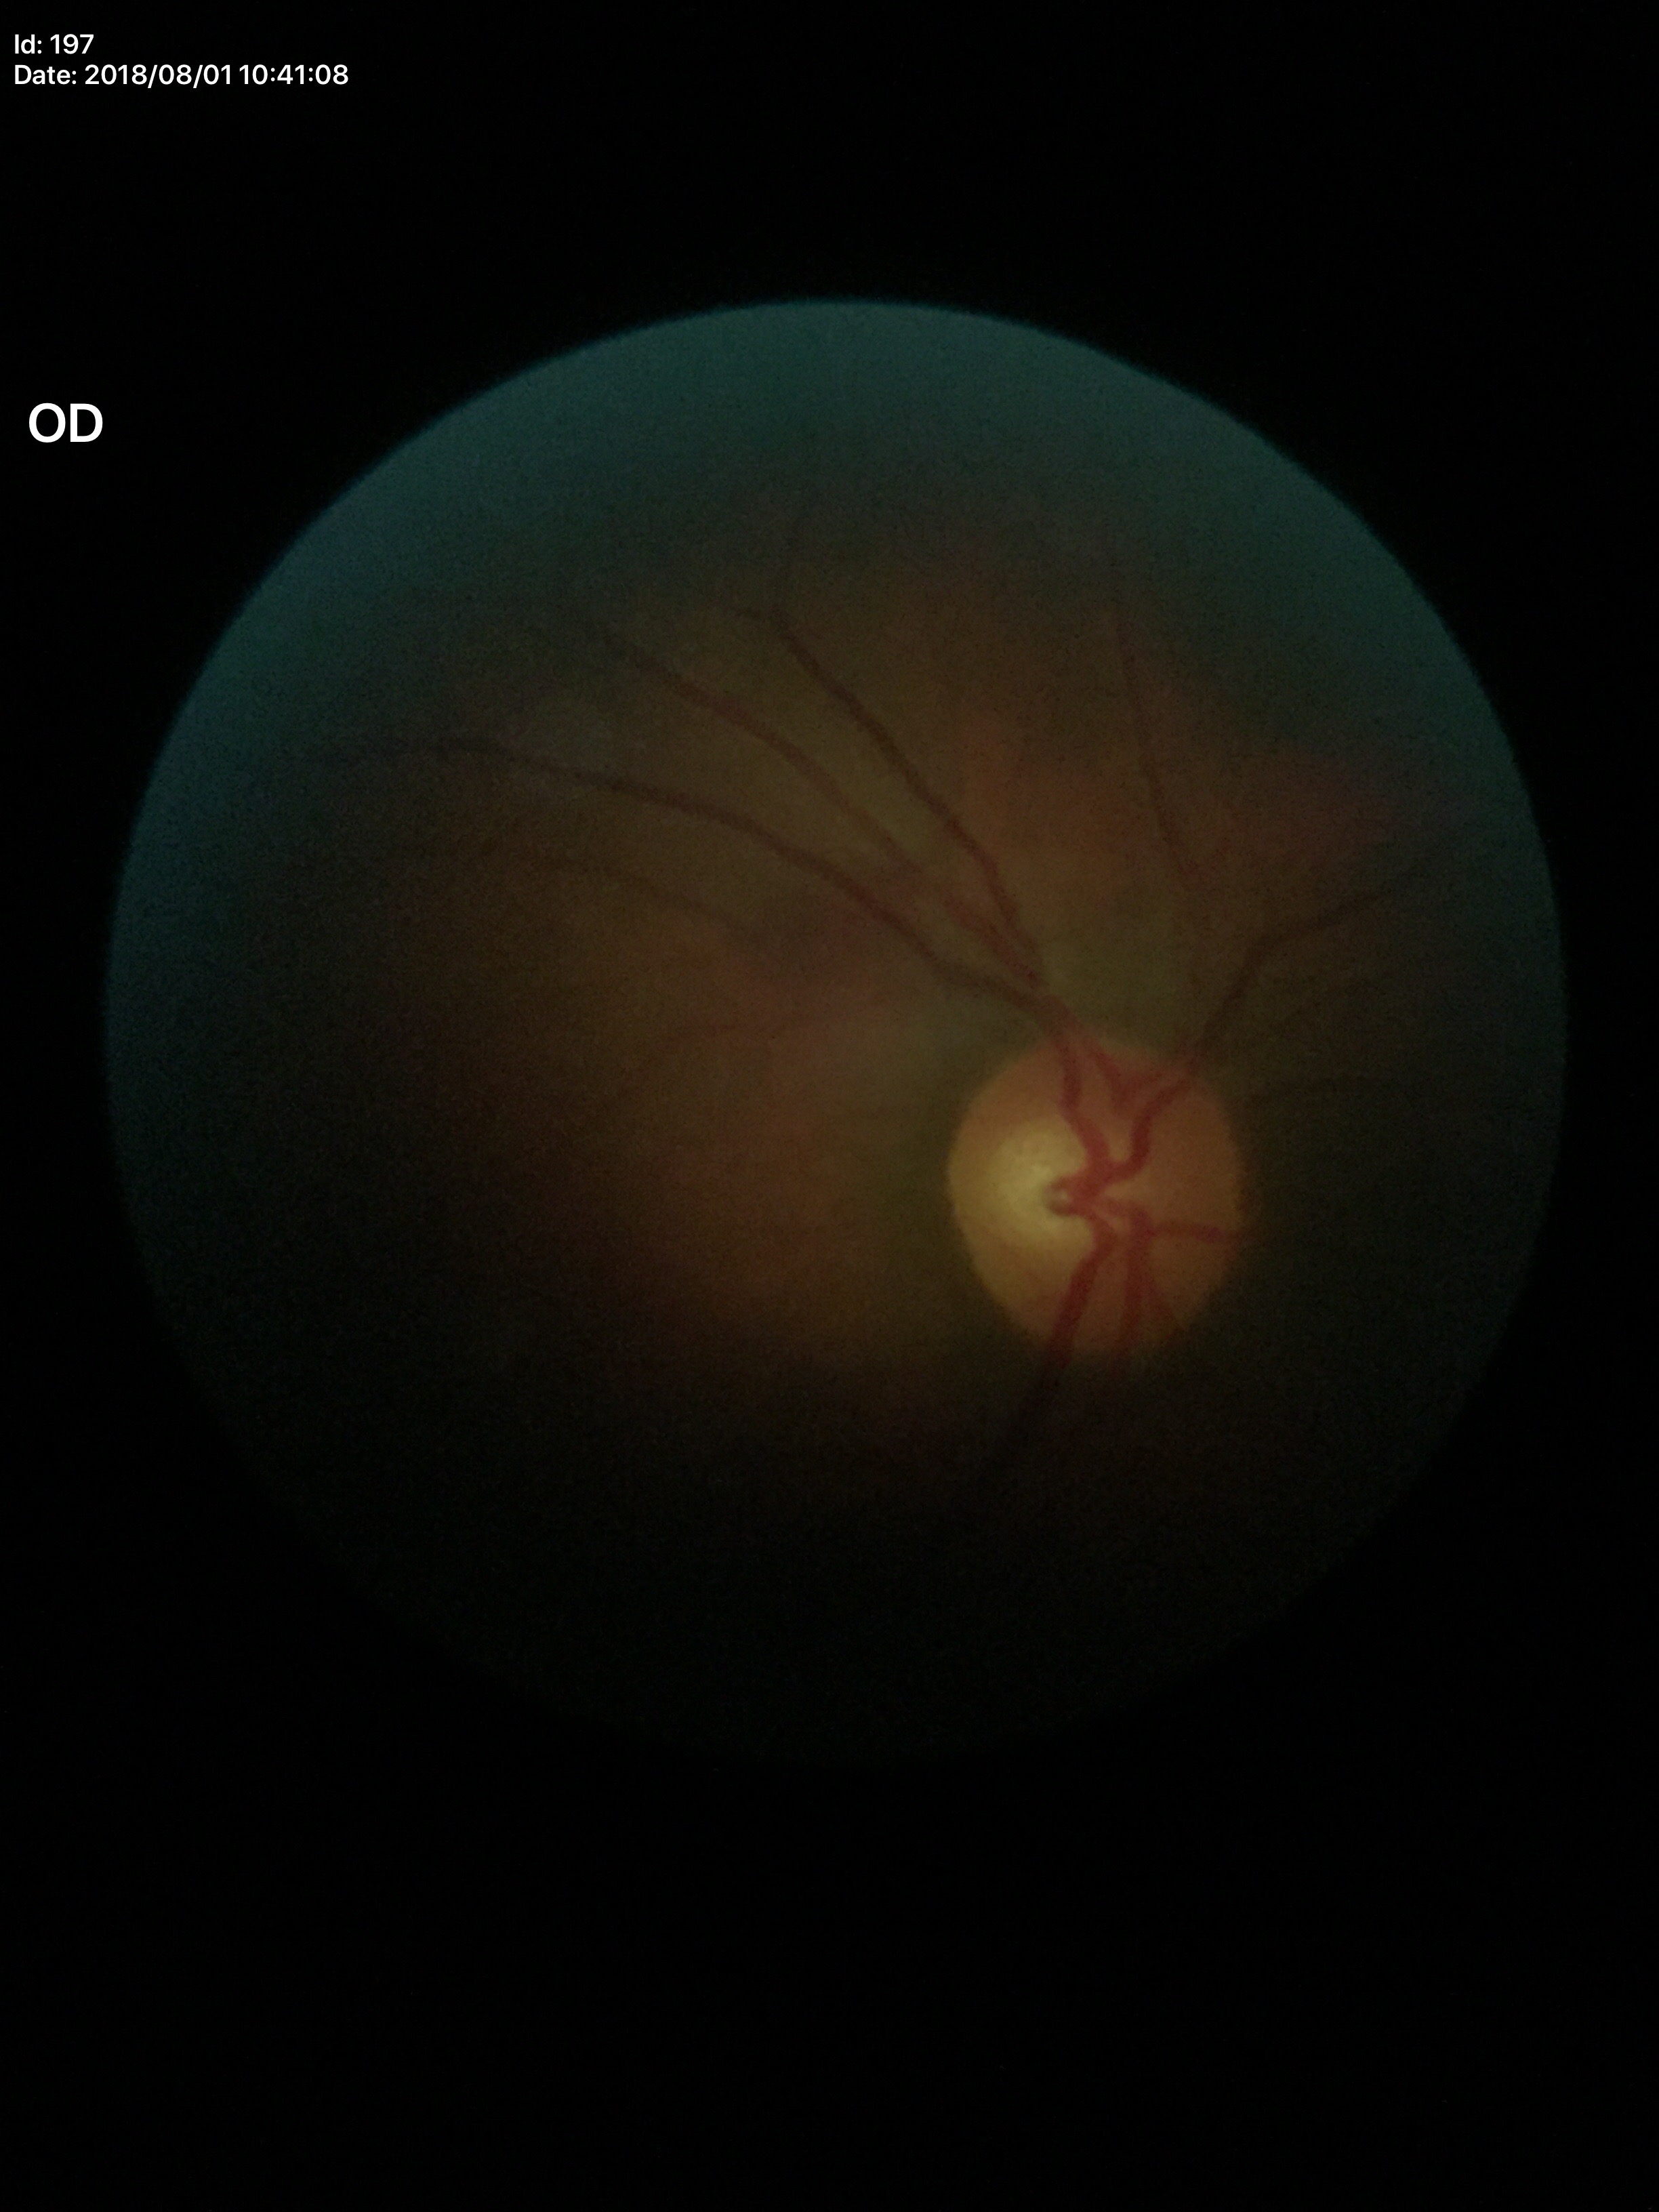 Glaucoma screening = no suspicious findings, vertical cup-to-disc ratio (VCDR) = 0.52.